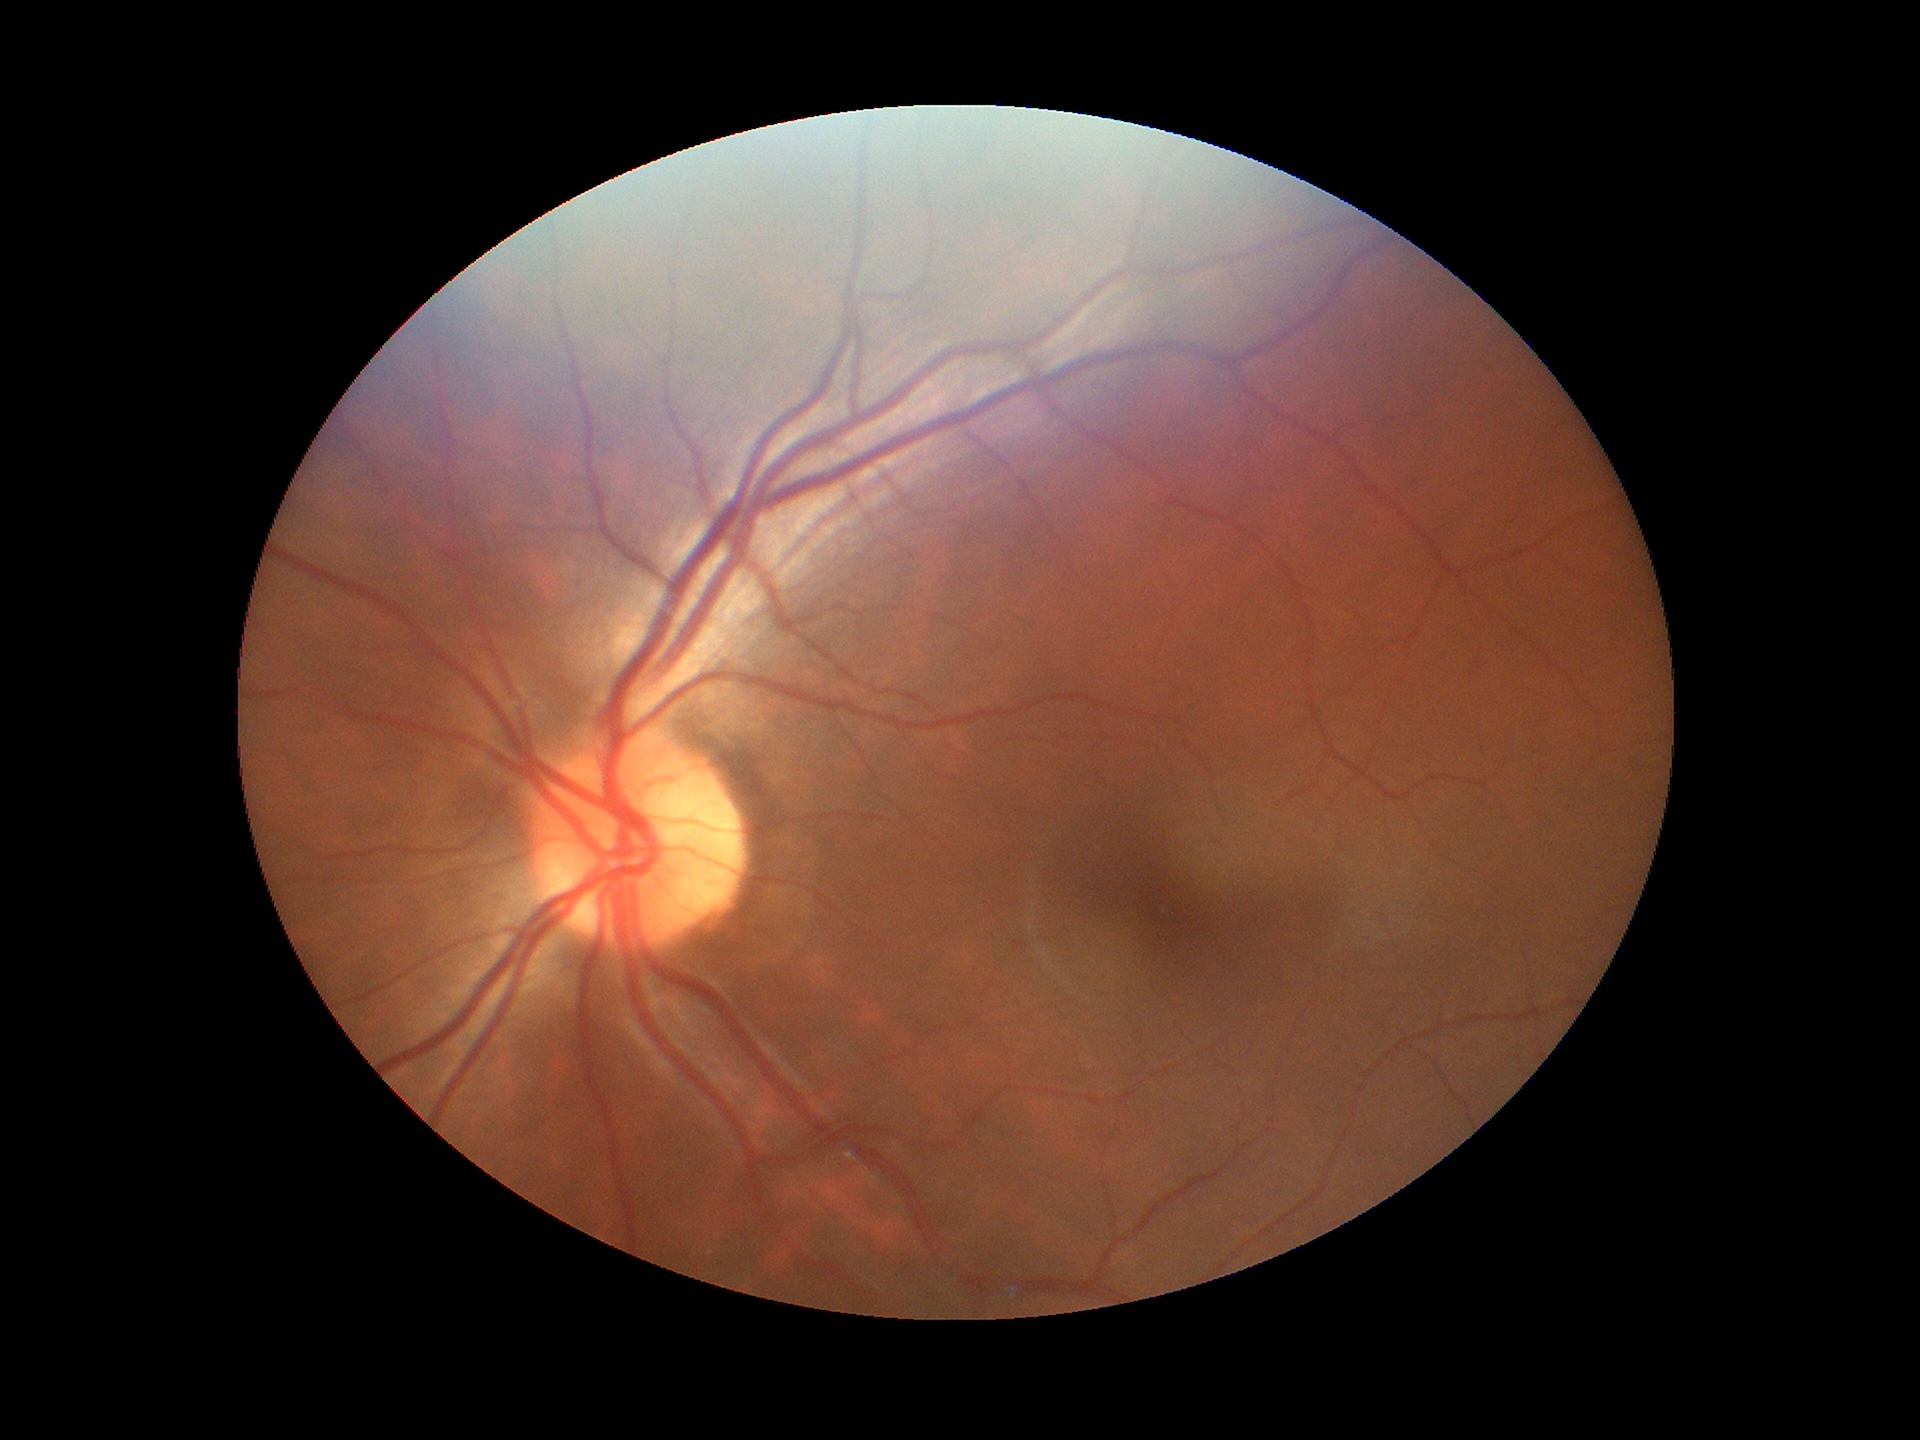
Negative for glaucoma suspicion (one of five ophthalmologists flagged glaucoma suspect). Vertical cup-disc ratio is 0.46.